2212x1659.
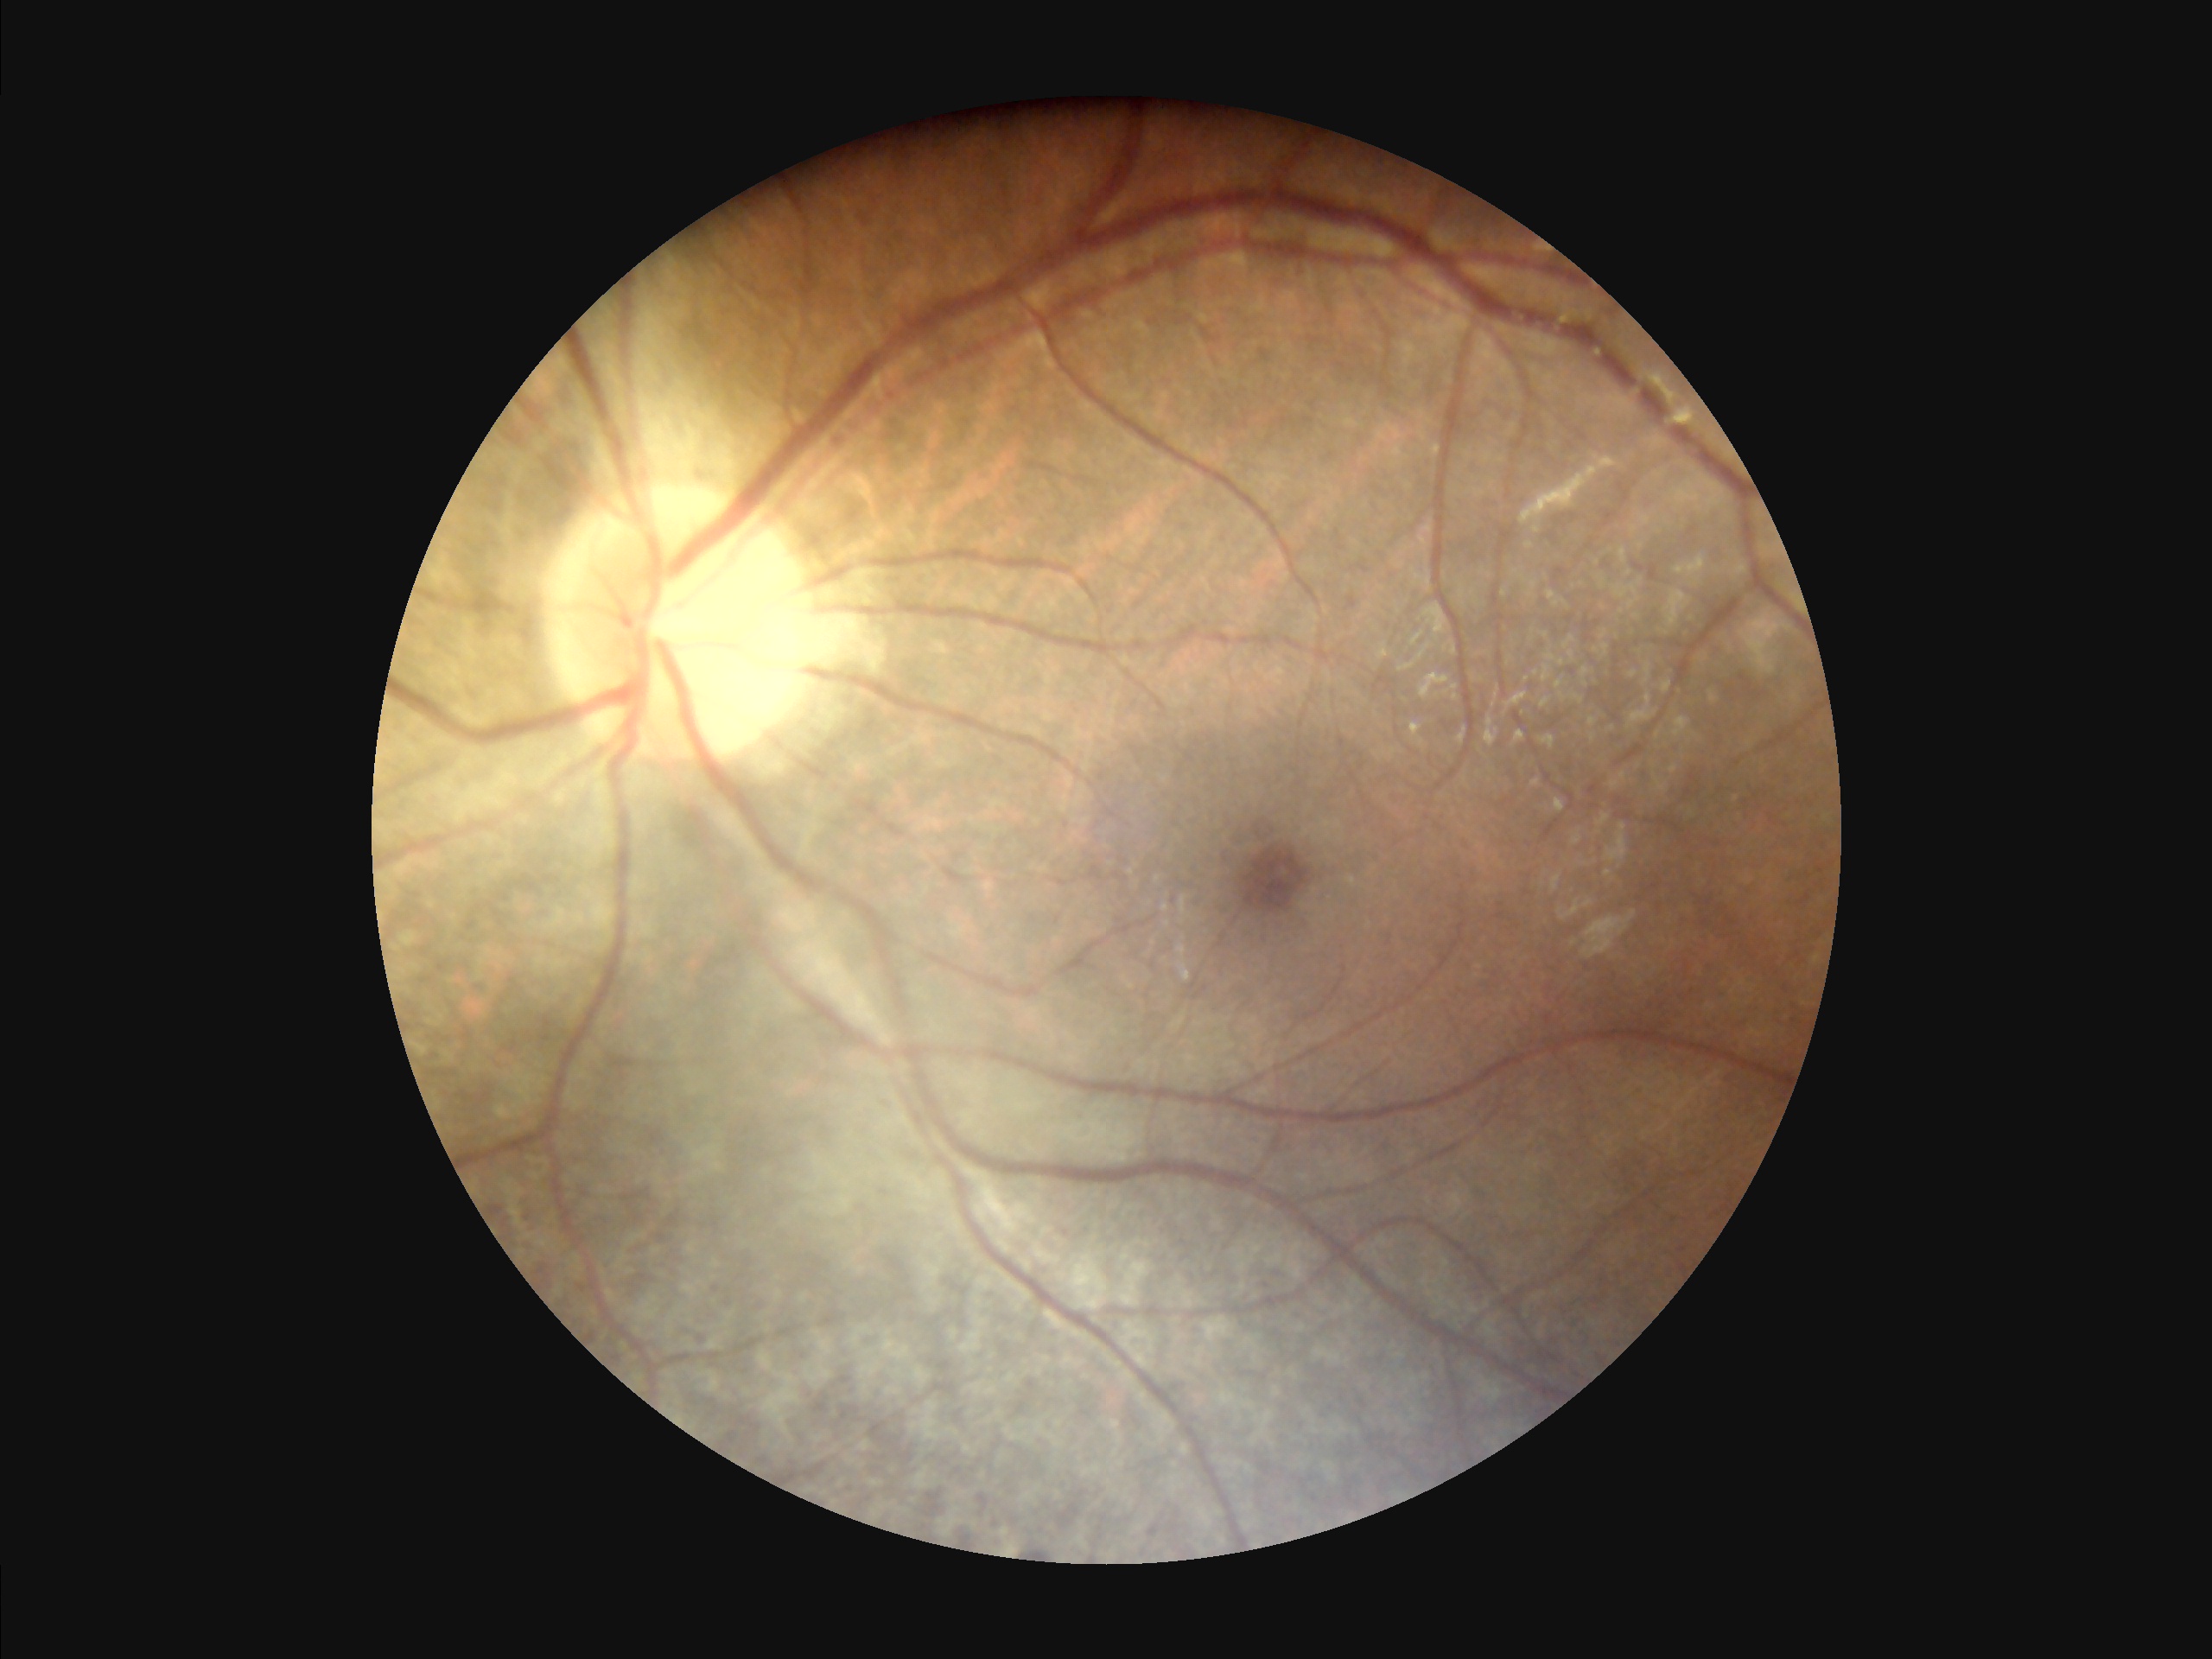
Poor illumination with uneven exposure. Acceptable image quality. The image is clear.